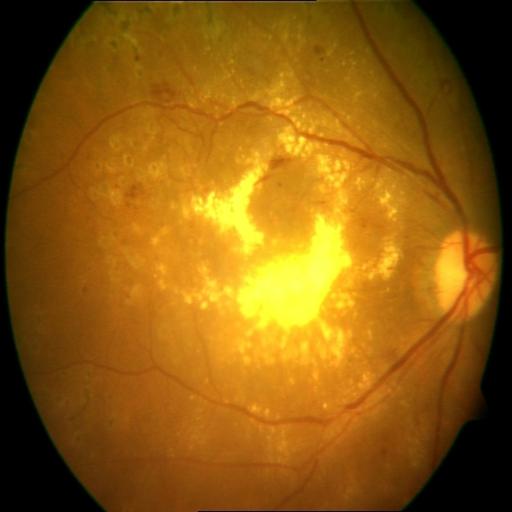
Pathology (3):
- exudation (EDN)
- hemorrhagic retinopathy (HR)
- cystoid macular edema (CME)